Image size 848x848
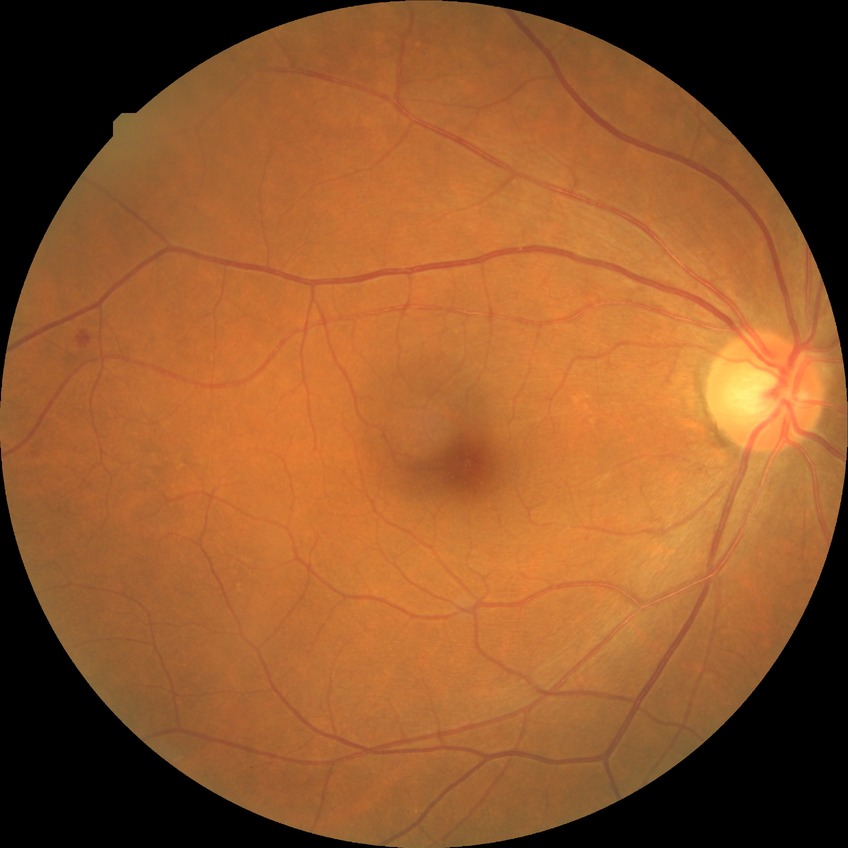

Retinopathy grade is no diabetic retinopathy.